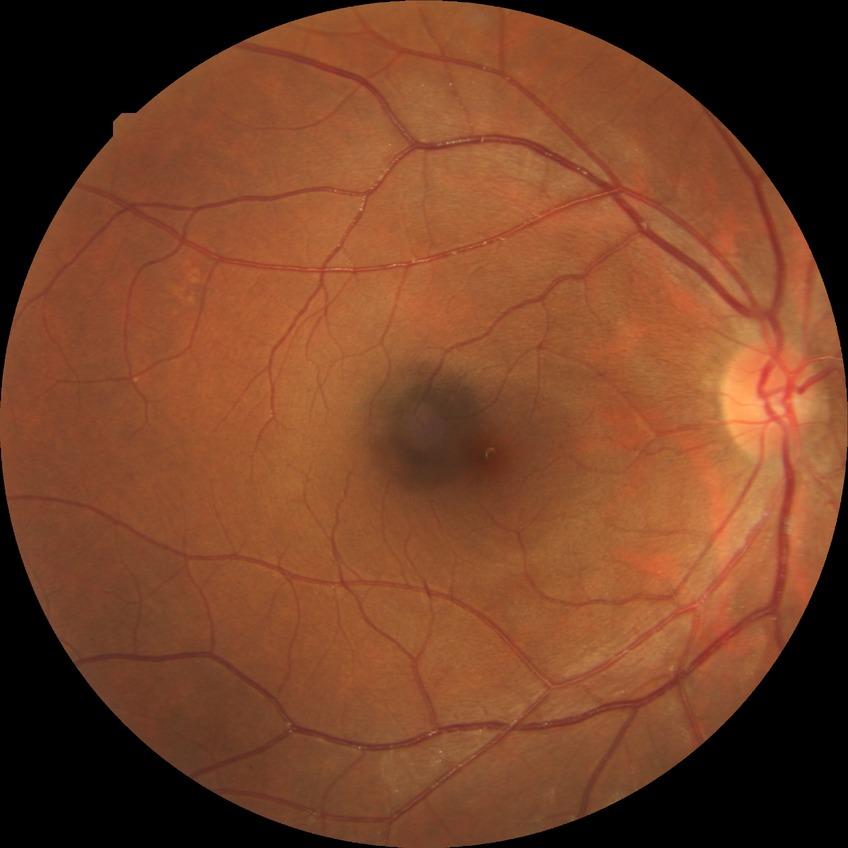 Diabetic retinopathy (DR) is no diabetic retinopathy (NDR).